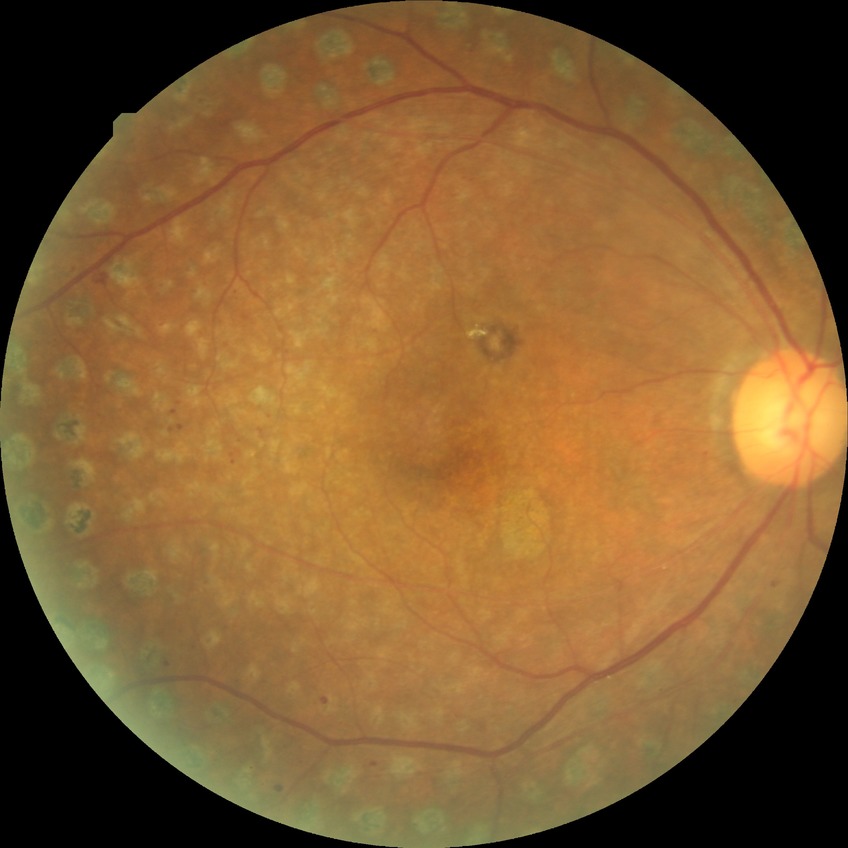

Diabetic retinopathy grade: proliferative diabetic retinopathy.